NIDEK AFC-230 — 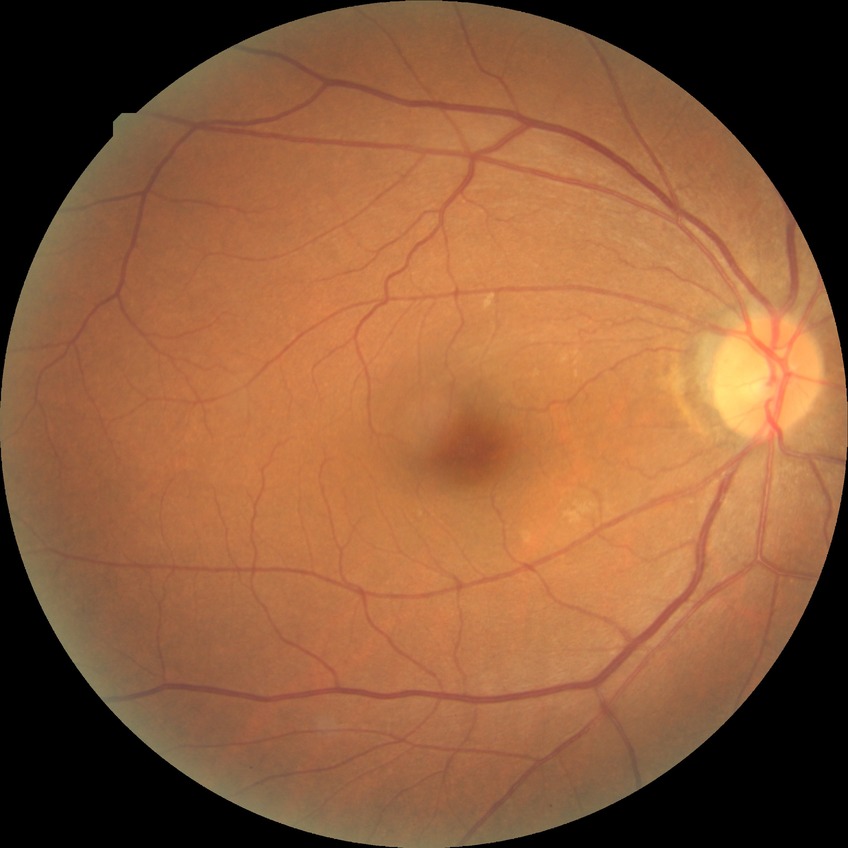 Diabetic retinopathy (DR) is no diabetic retinopathy (NDR).